CFP: 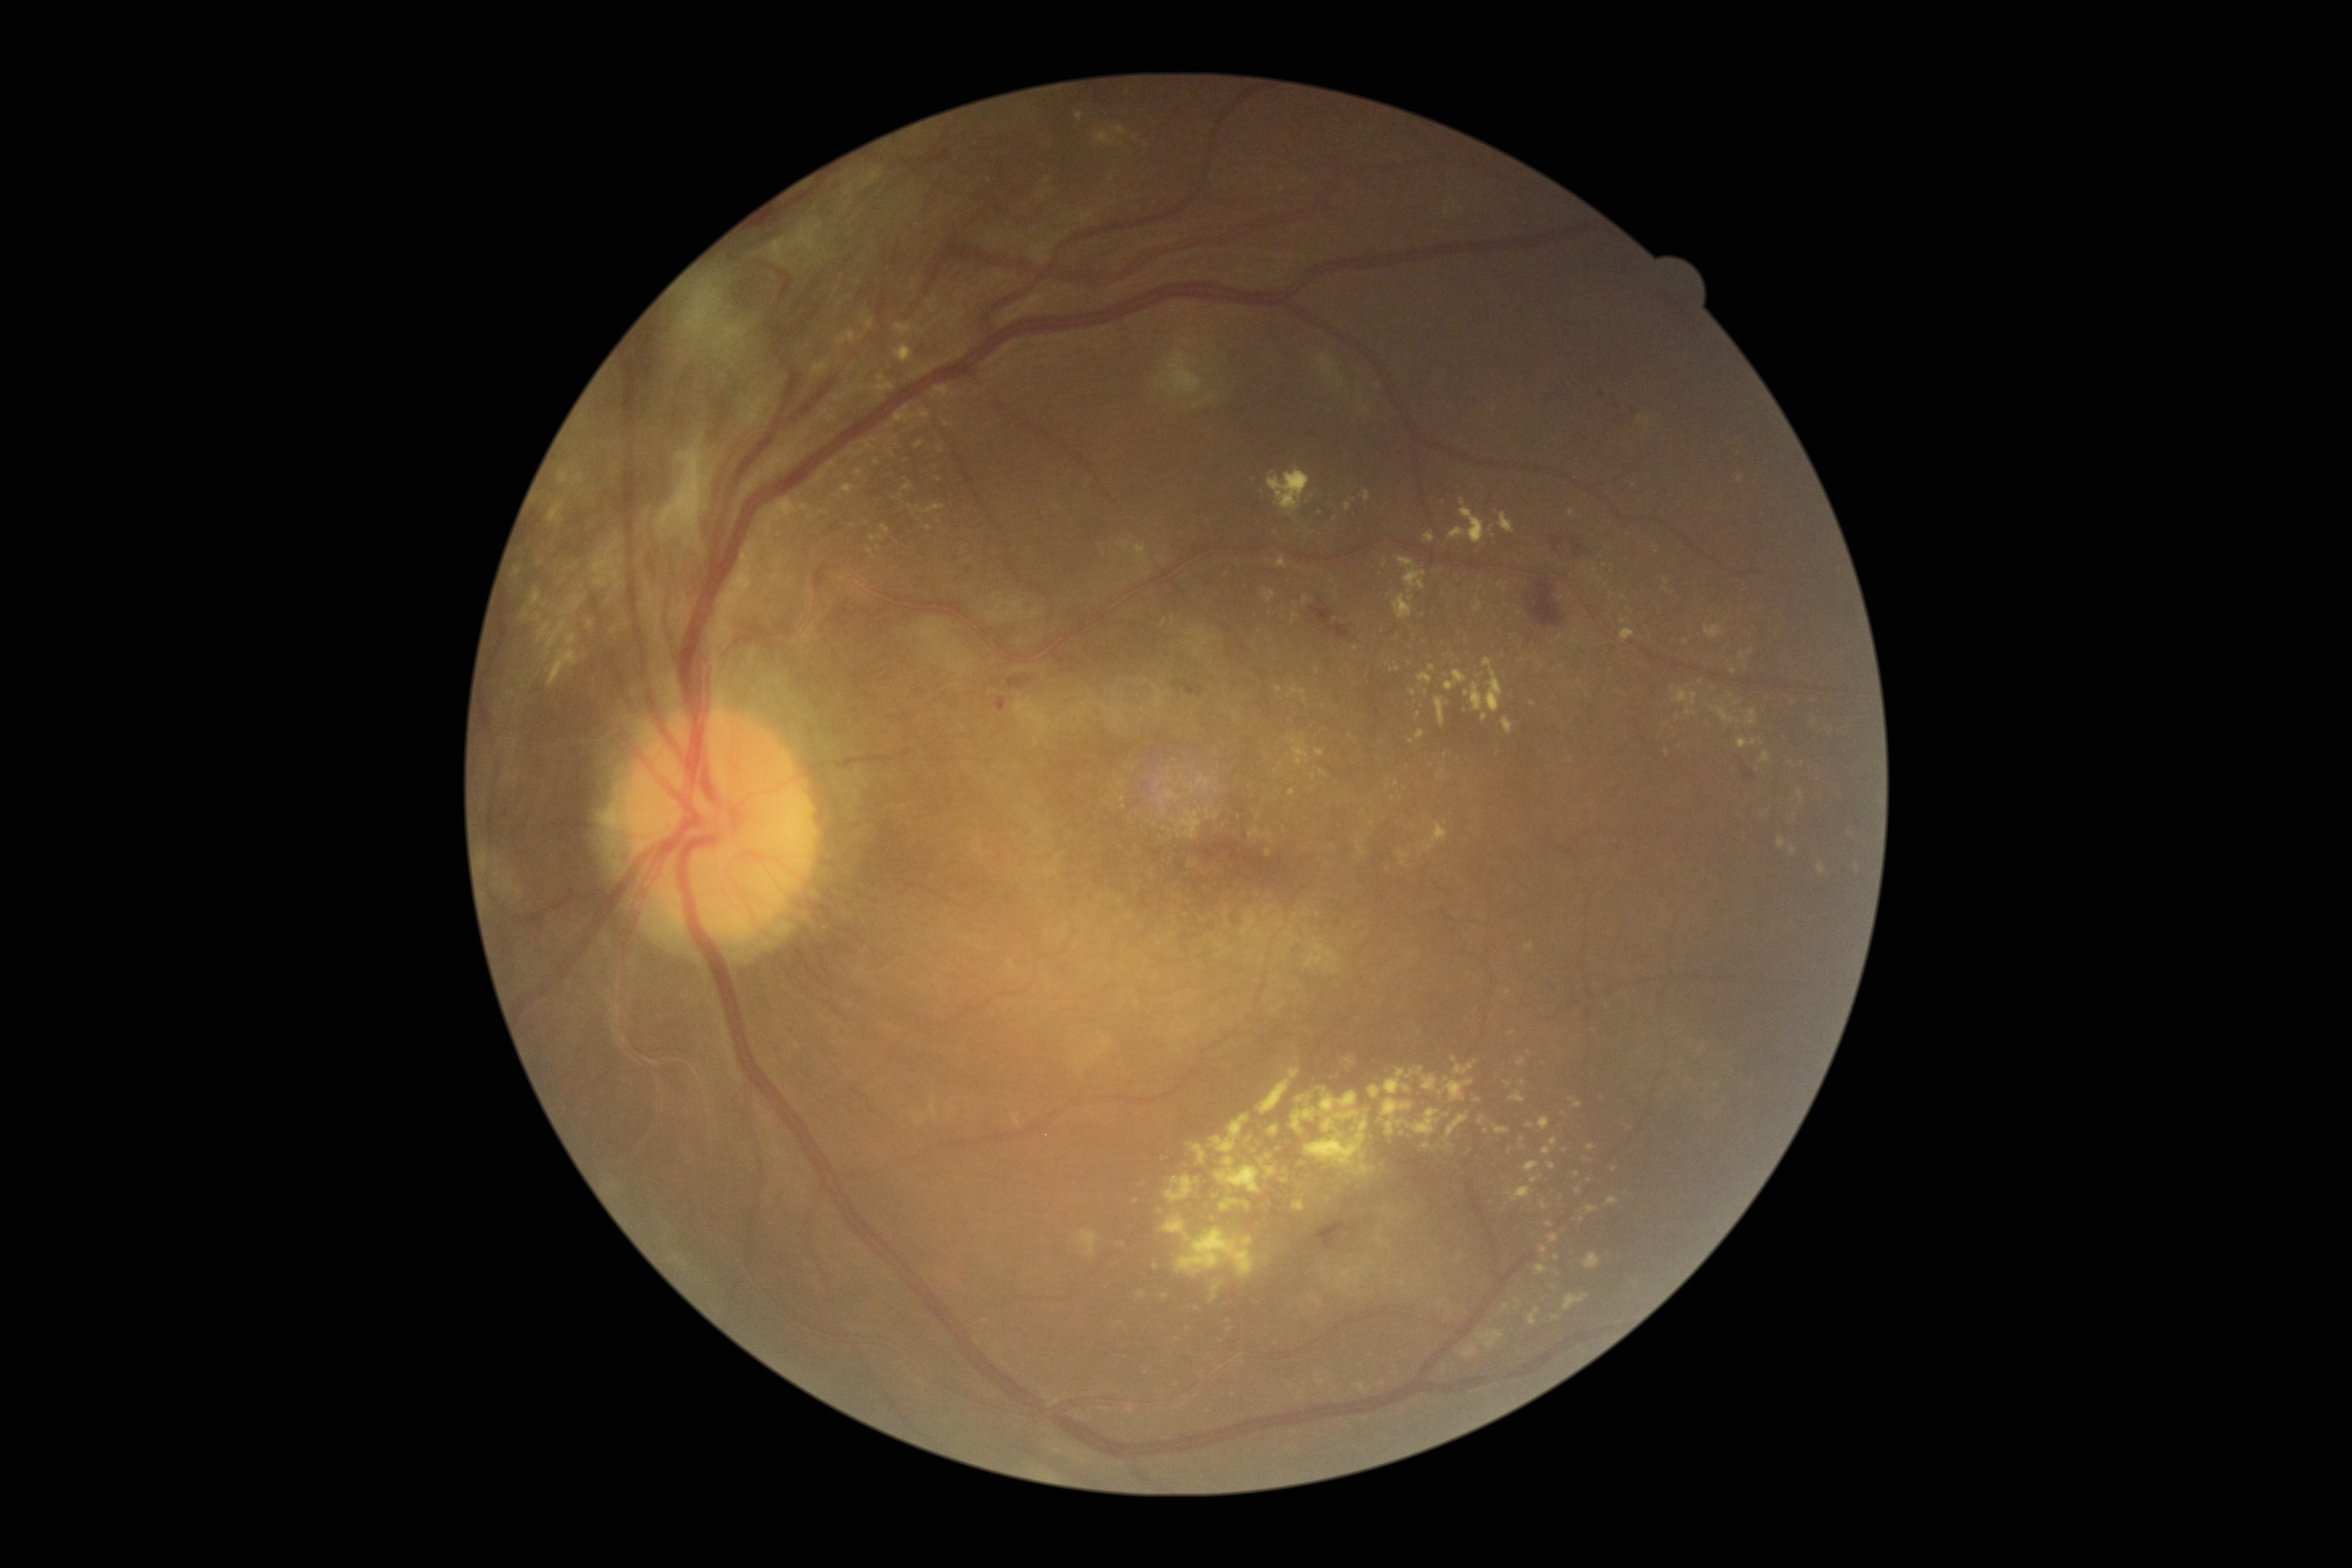

Retinopathy is grade 4 (PDR)
A subset of detected lesions:
hard exudates (continued): 935/385/950/397 | 1092/126/1128/146 | 1187/1144/1208/1165 | 834/394/848/402 | 1394/556/1427/592 | 1391/666/1400/672 | 1535/1265/1548/1276 | 1474/602/1483/612 | 812/360/829/376 | 1292/613/1299/622
Additional small hard exudates near [1402,1284] | [1577,1173] | [1686,641] | [1292,791] | [876,462] | [1249,1139] | [1678,716] | [1738,721] | [1198,1308]